Wide-field fundus image from infant ROP screening — 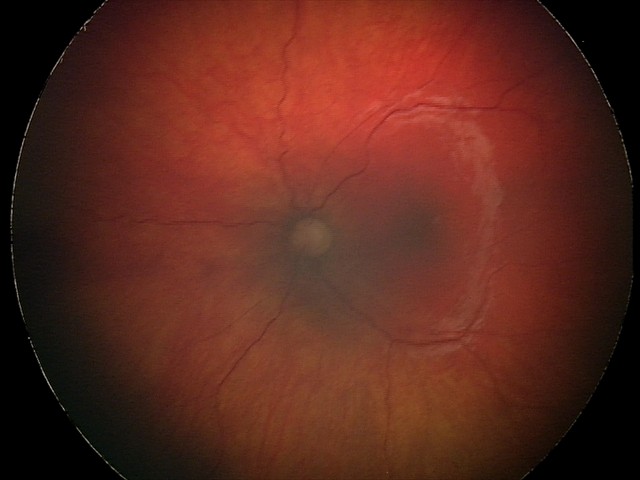 Finding: optic nerve hypoplasia.